50-degree field of view
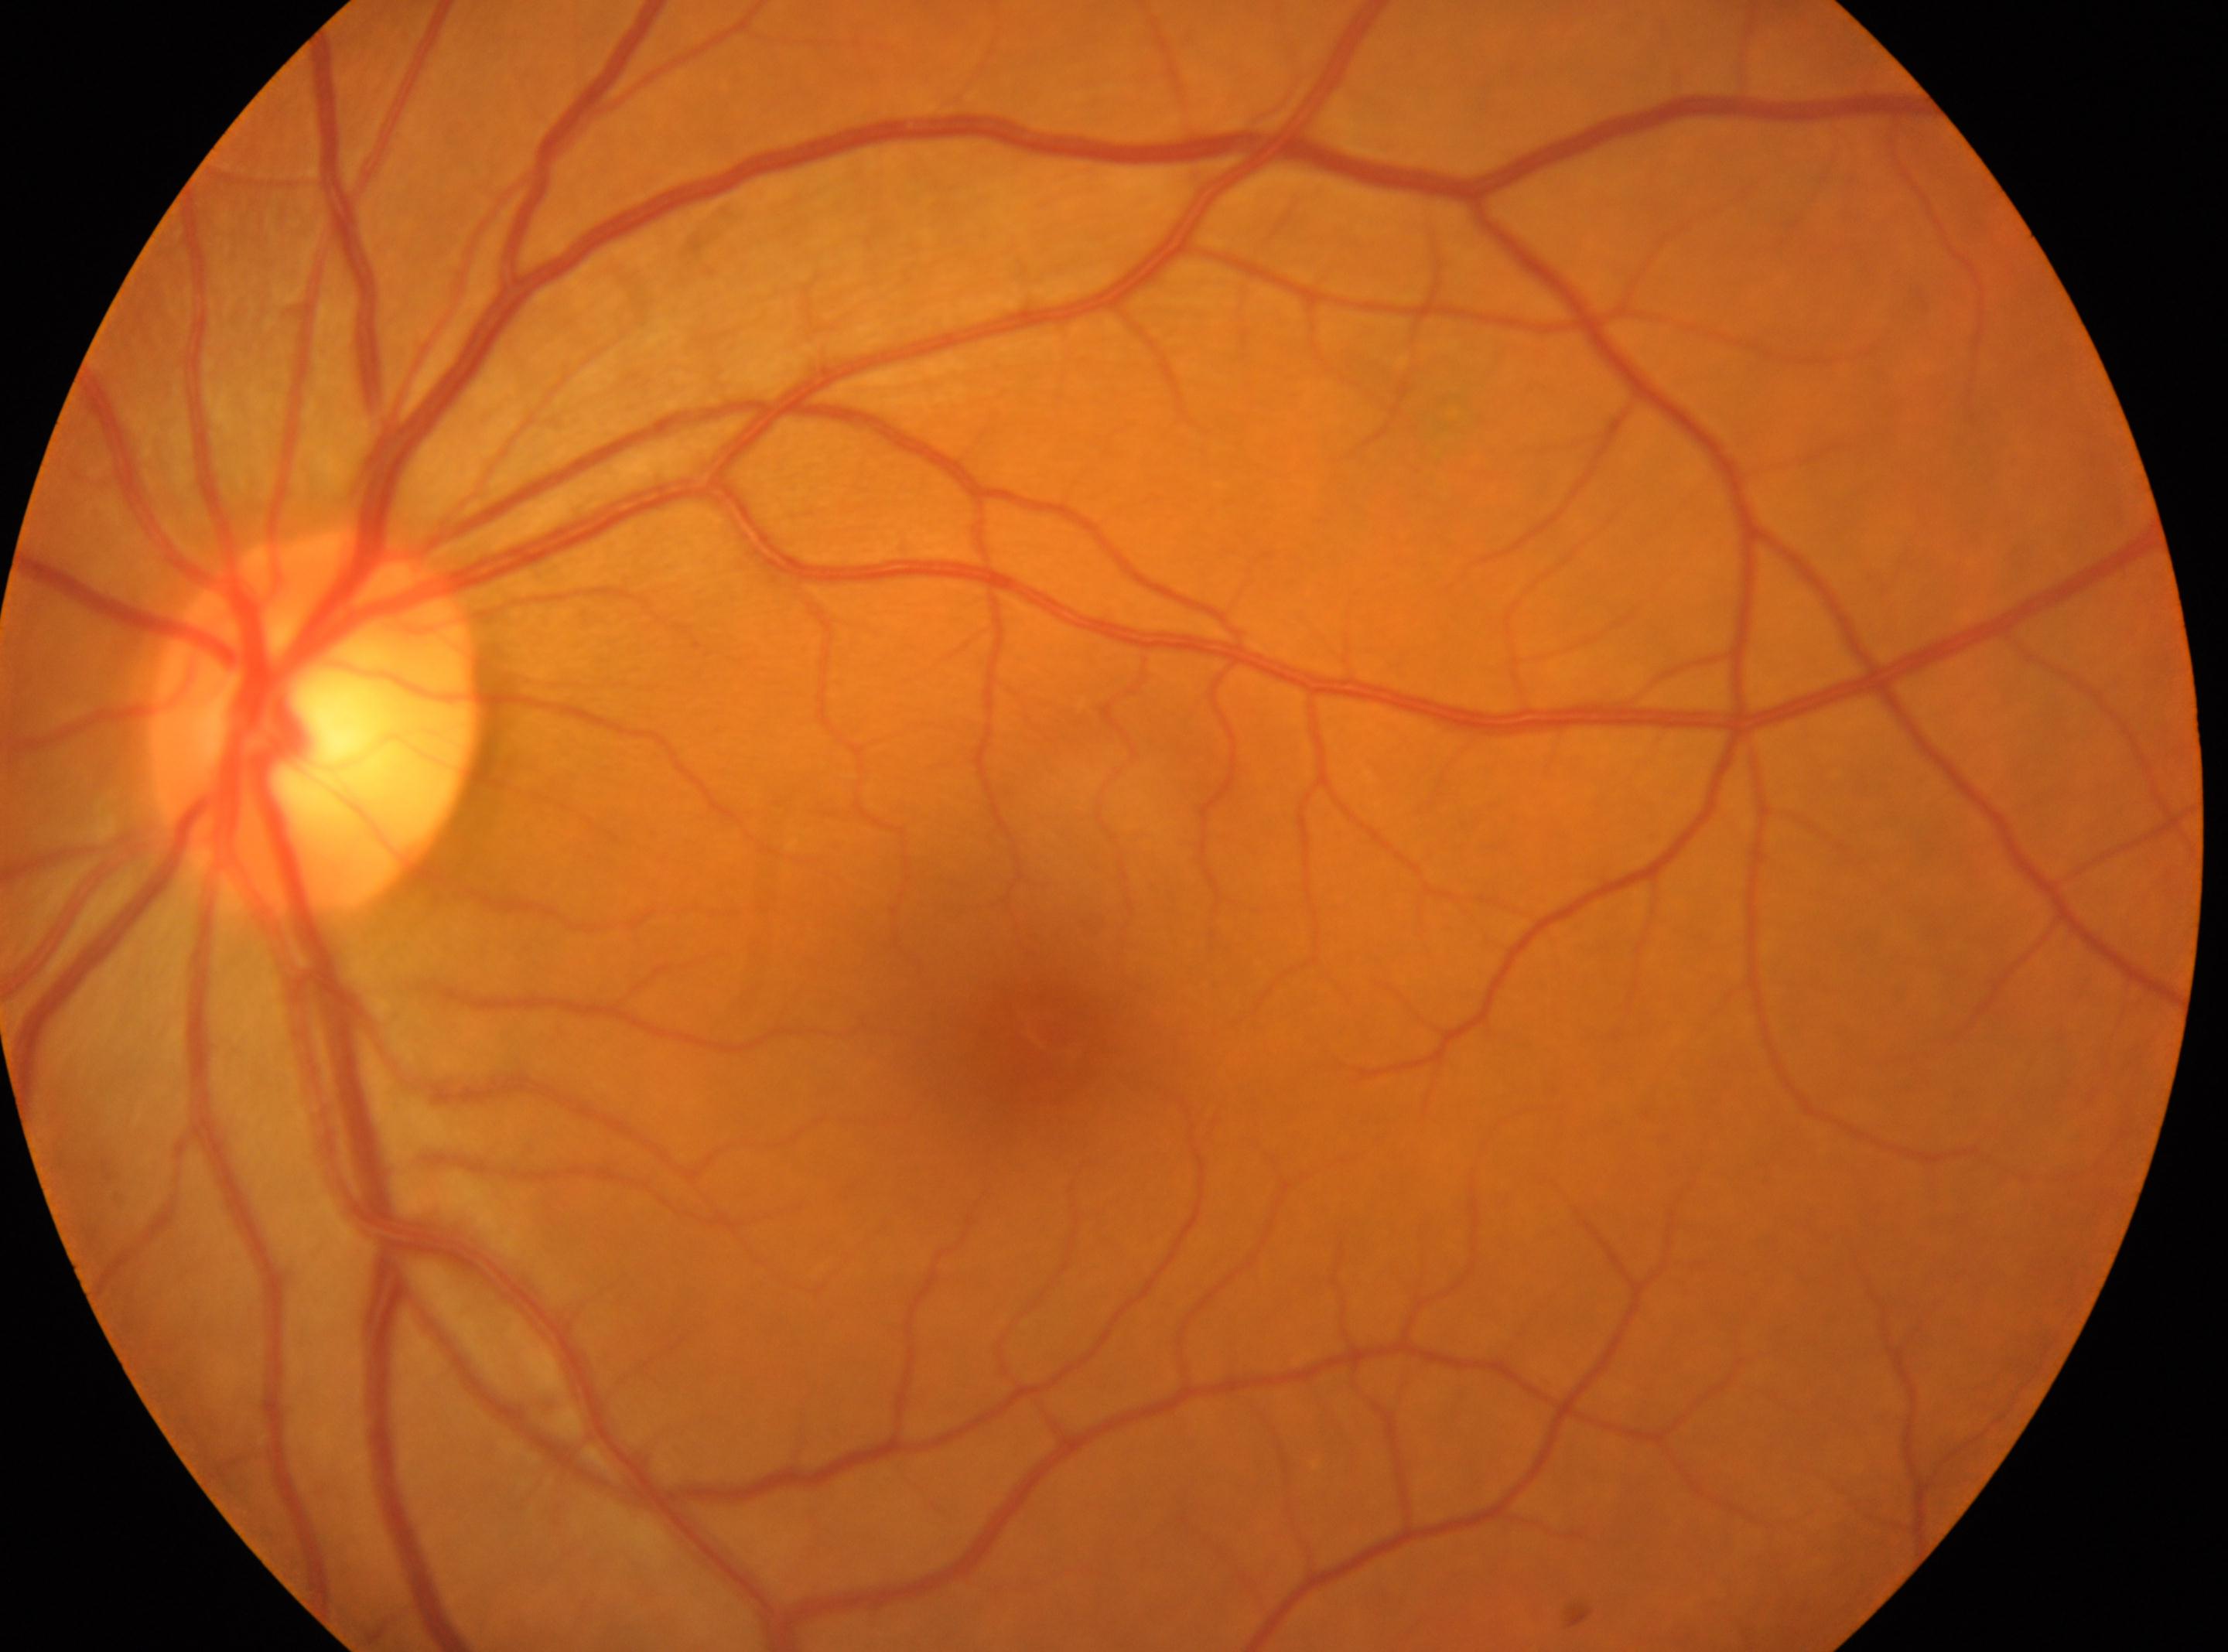
Retinopathy grade: 0 (no apparent retinopathy).
This is the left eye.
Optic nerve head located at (316,721).
Fovea located at (1051,1032).